45° field of view. 2352 by 1568 pixels. Color fundus photograph — 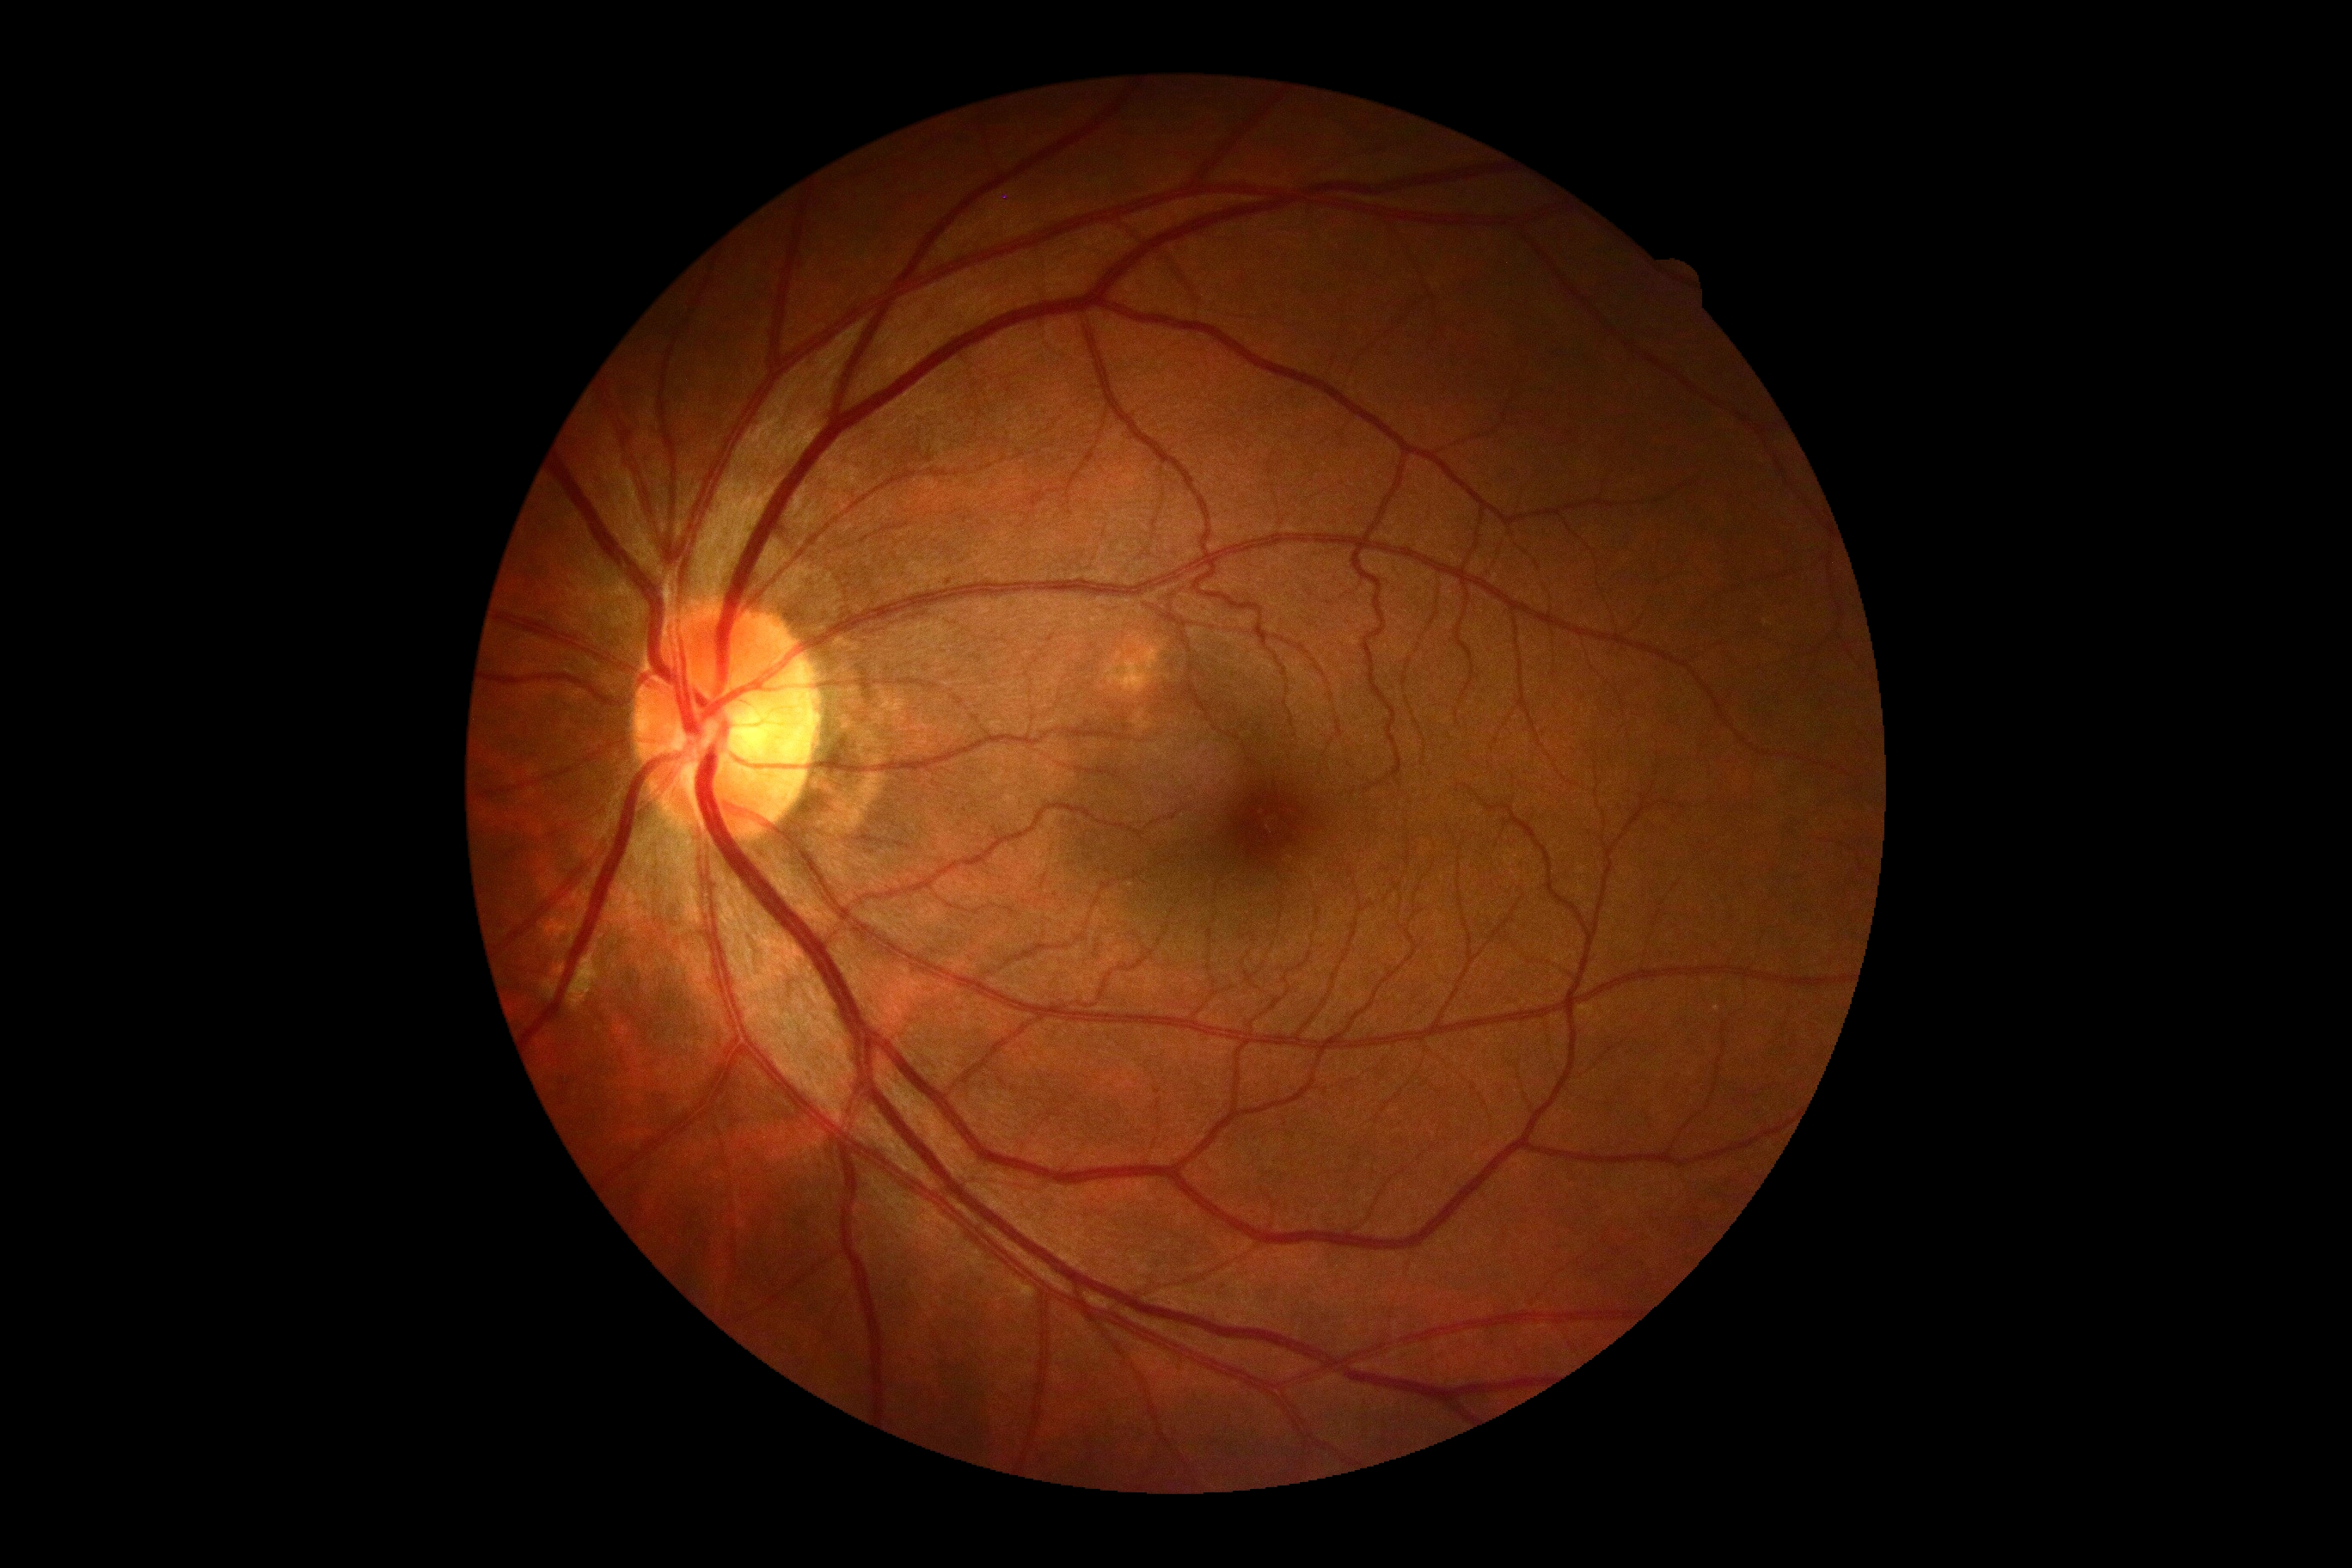

DR severity@0/4; DR impression@negative for DR.